Fundus photo:
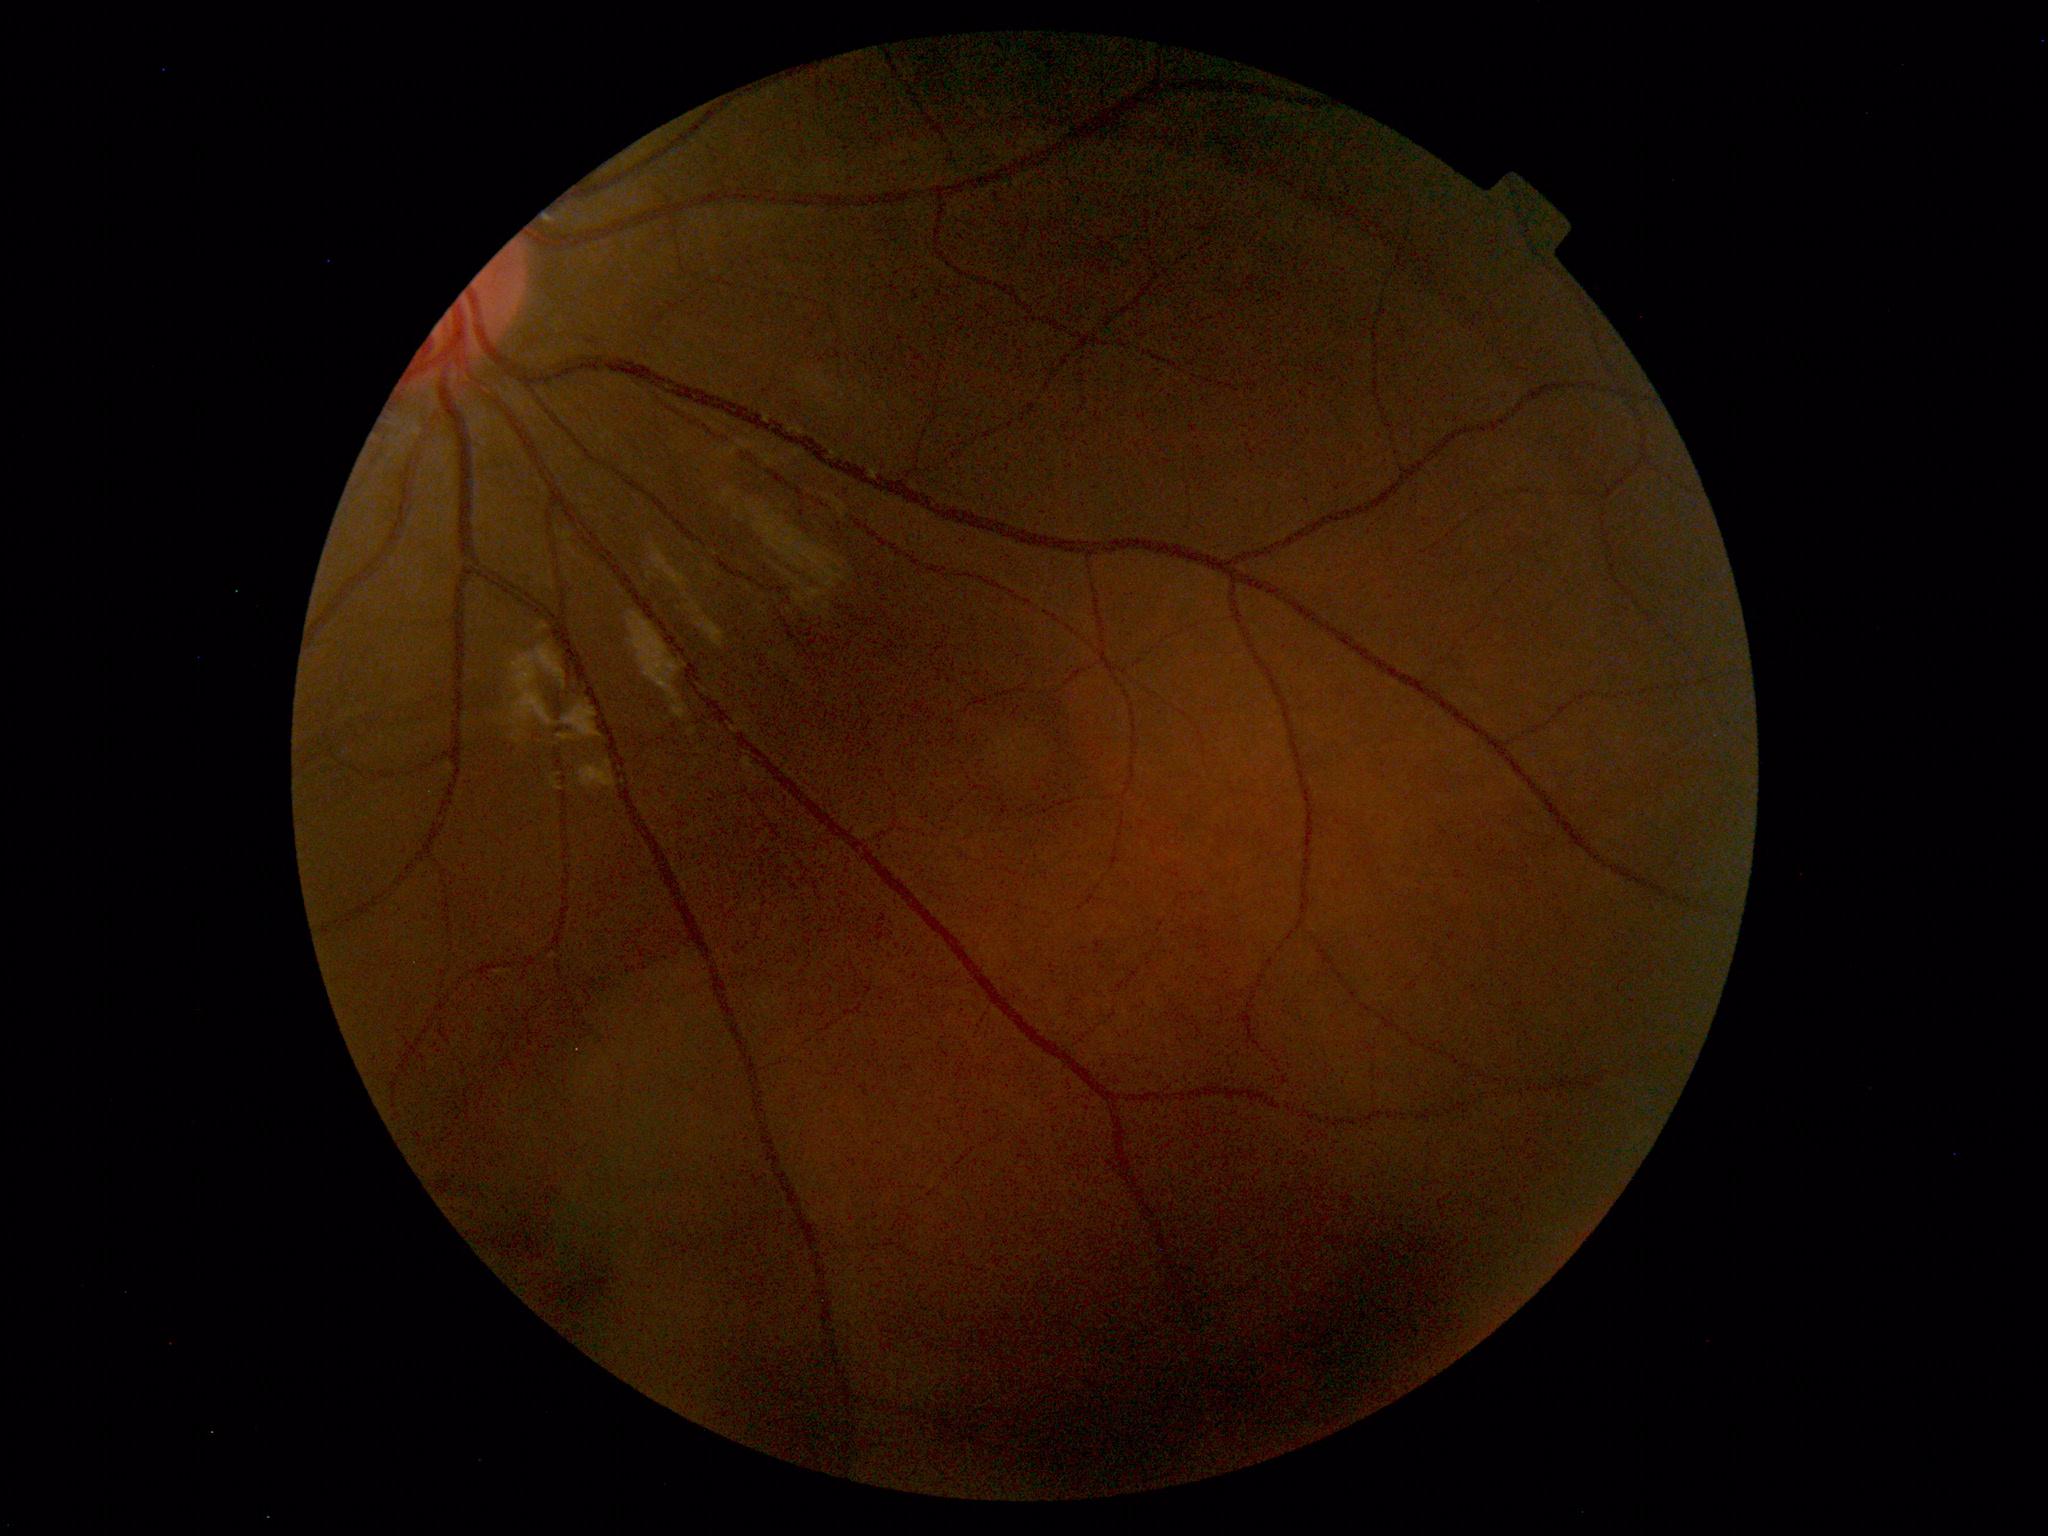 The fundus appears normal with no pathological findings.